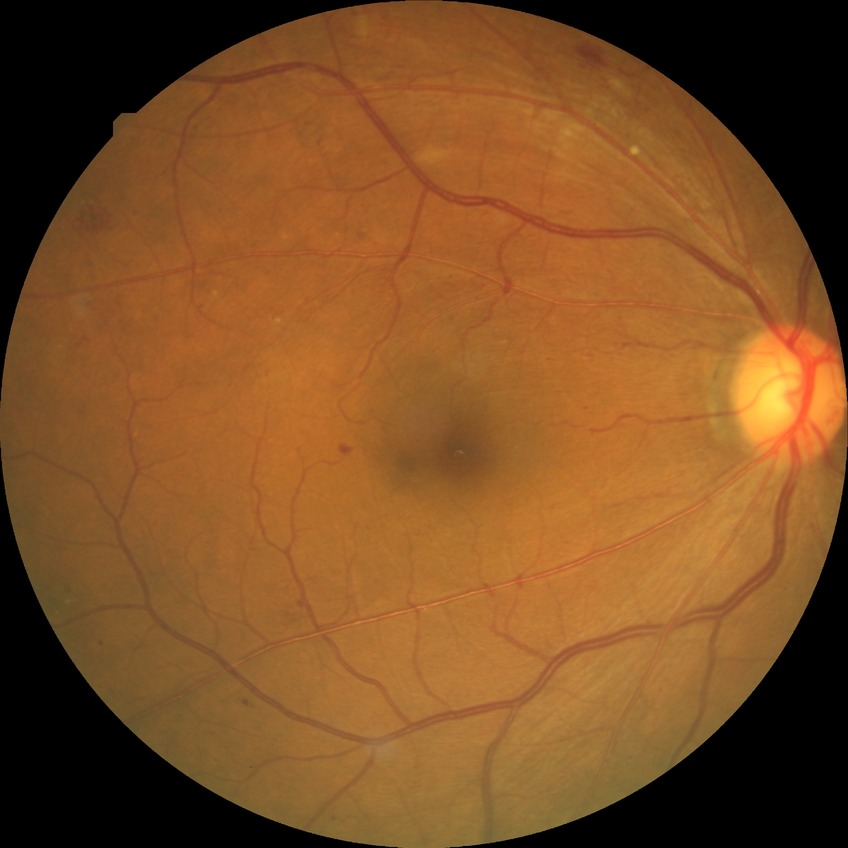

Diabetic retinopathy (DR): simple diabetic retinopathy (SDR). DR class: non-proliferative diabetic retinopathy.